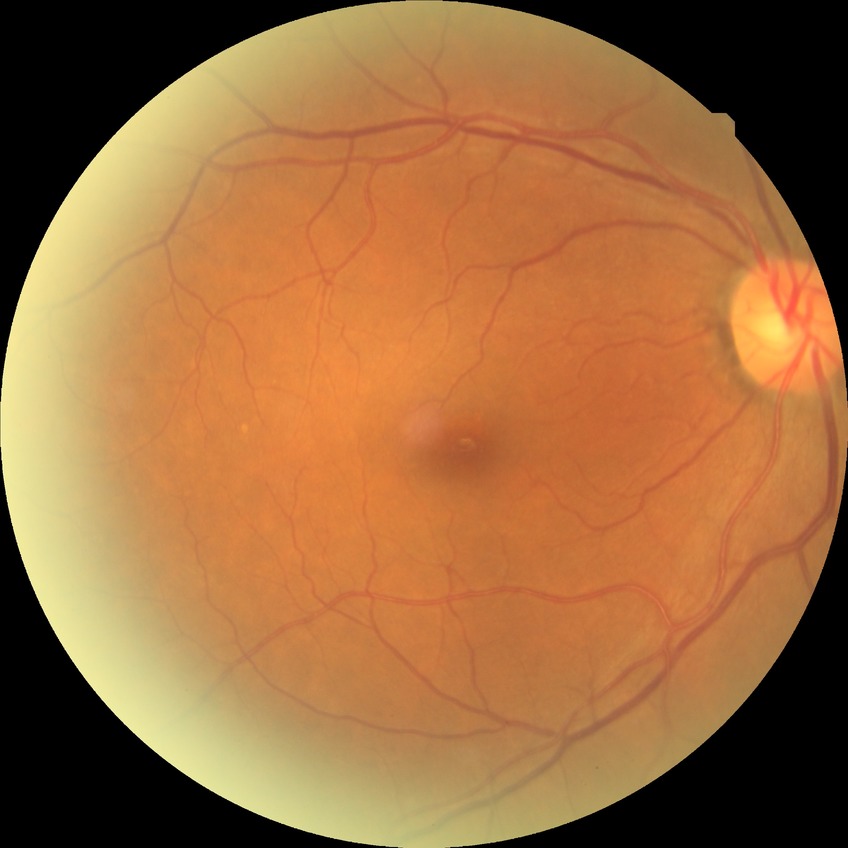
Diabetic retinopathy (DR) is NDR (no diabetic retinopathy).